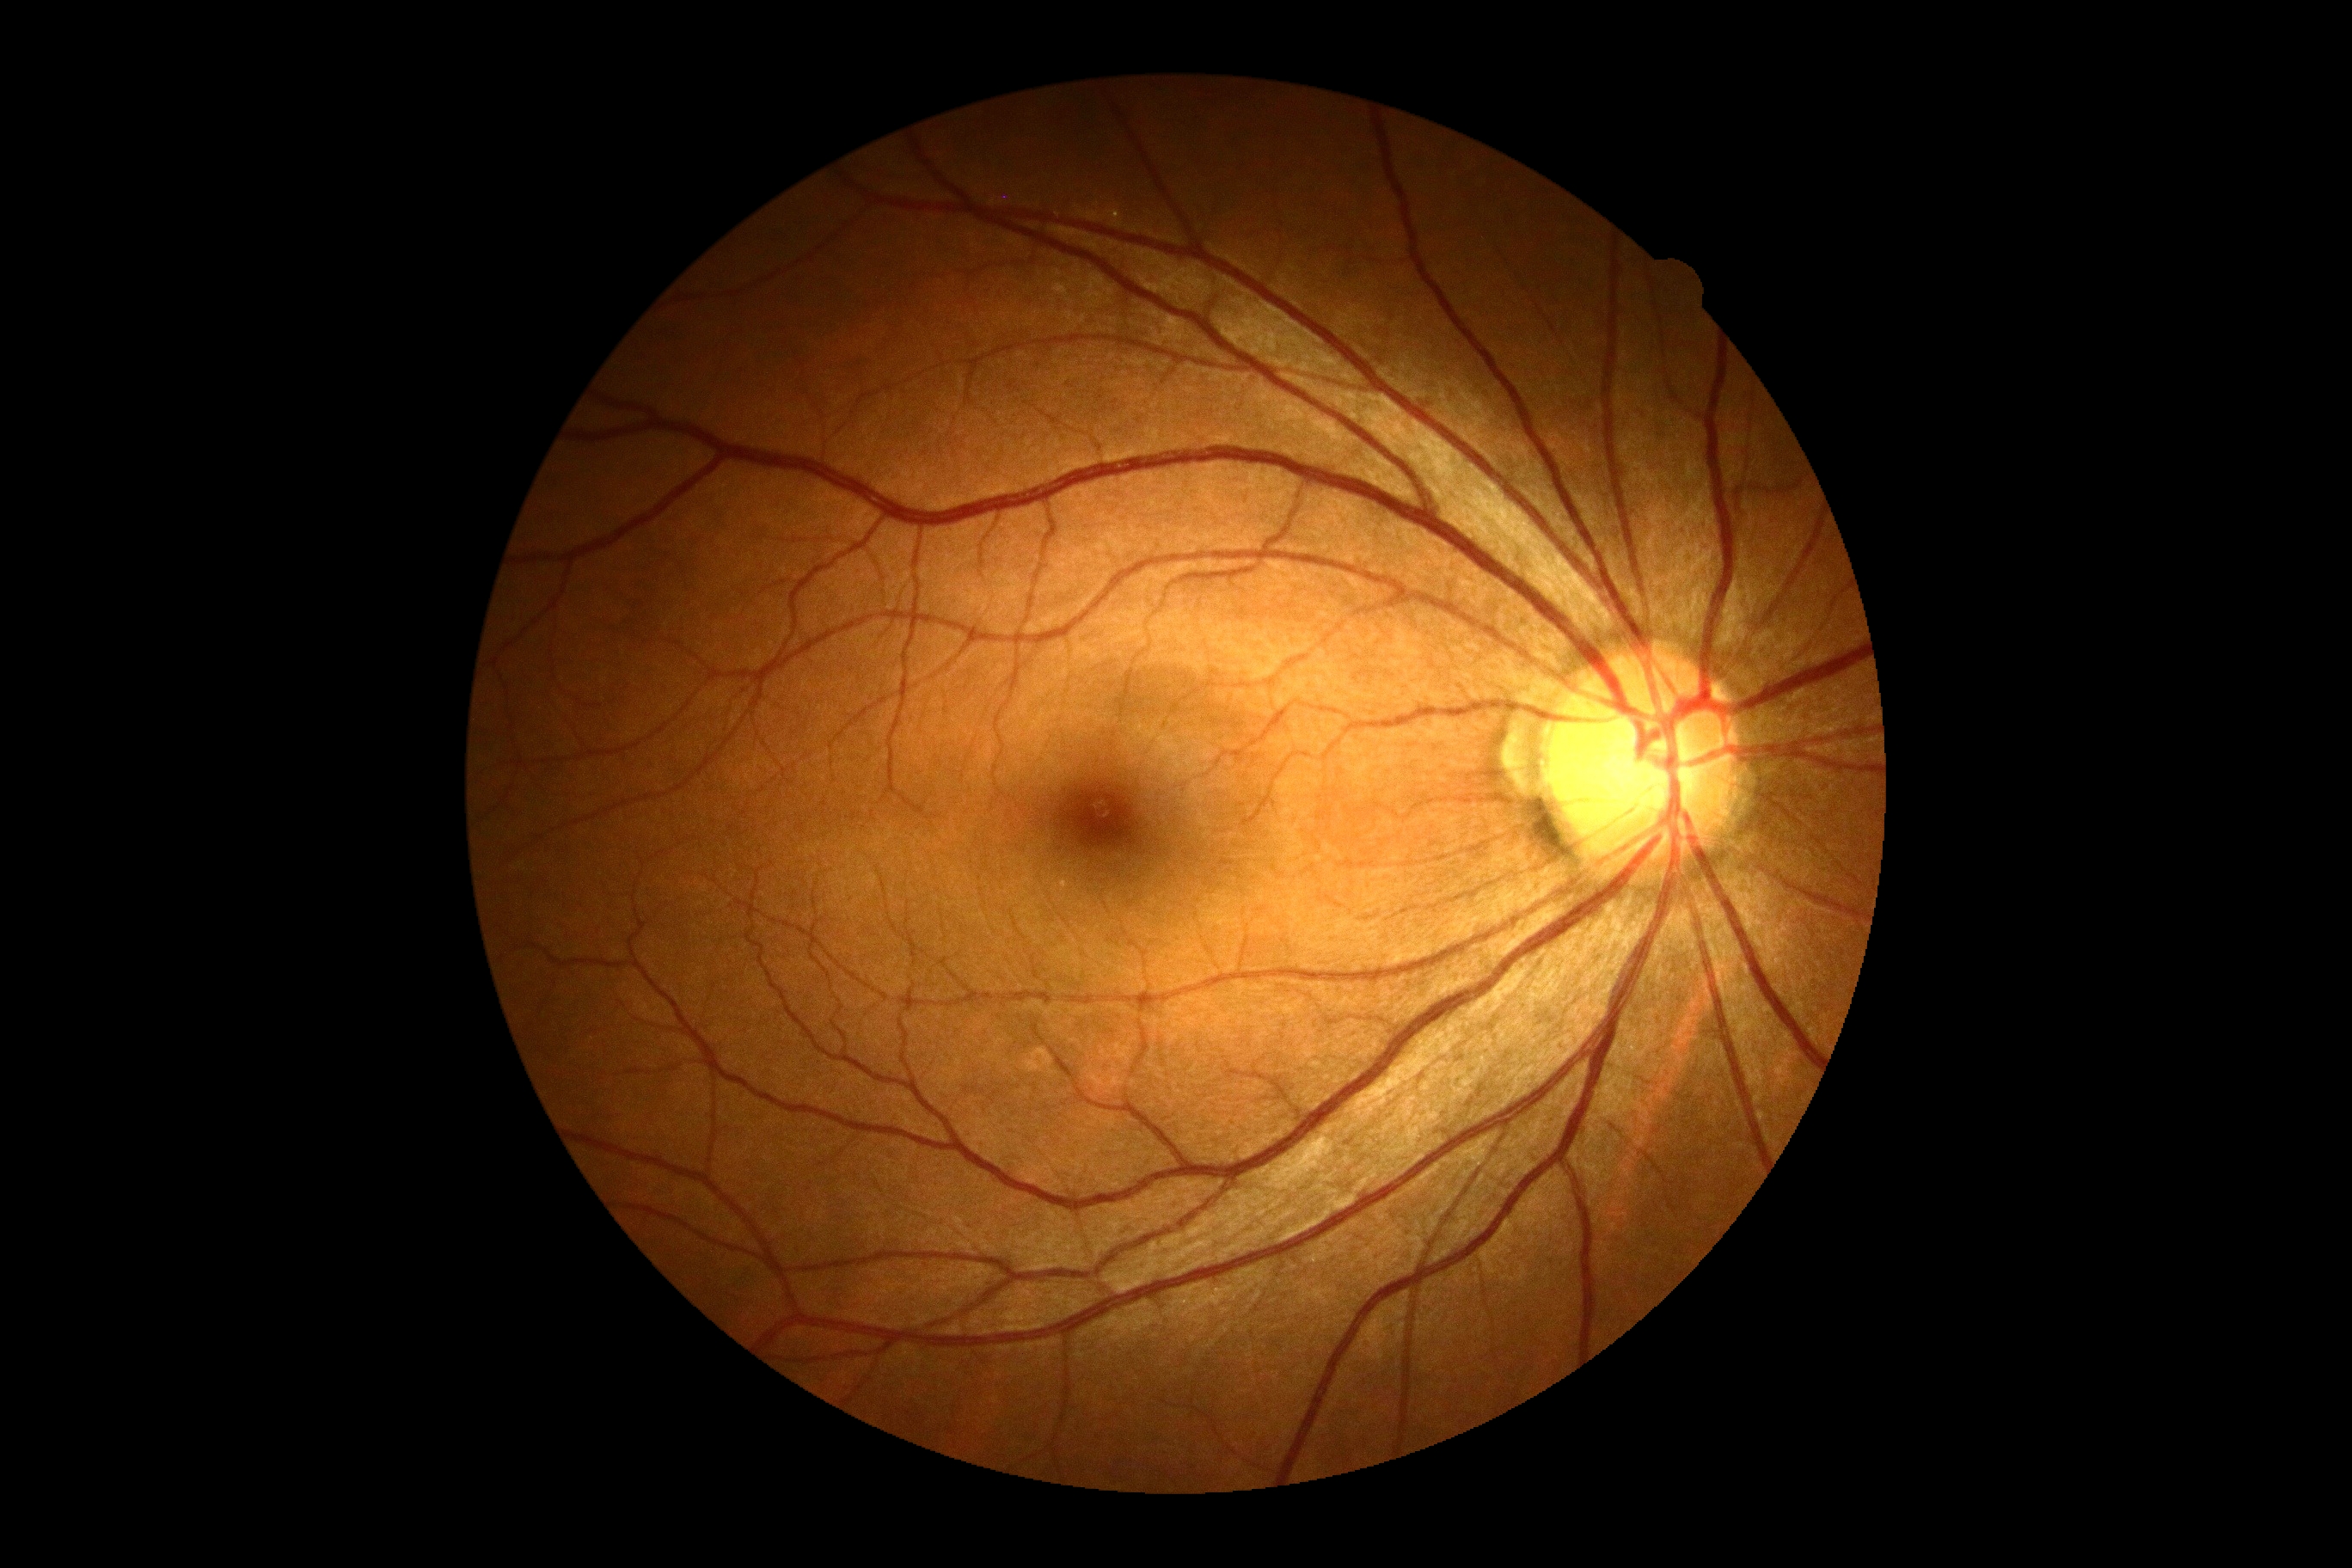 {
  "dr_grade": "no apparent diabetic retinopathy (0)"
}